Acquired with a NIDEK AFC-230, 45 degree fundus photograph:
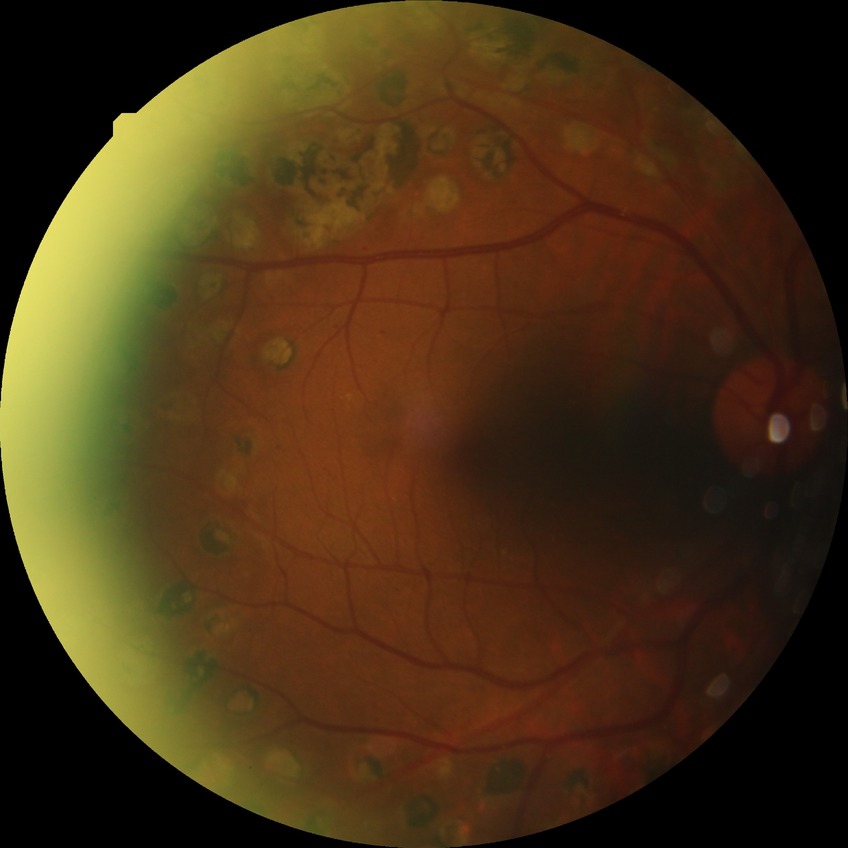
Diabetic retinopathy grade is proliferative diabetic retinopathy.